Fundus photo — 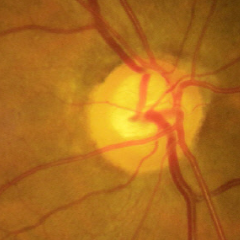 Glaucoma is present. Demonstrates early glaucoma. Diagnostic criteria: glaucomatous retinal nerve fiber layer defects on red-free fundus photography without visual field defects.